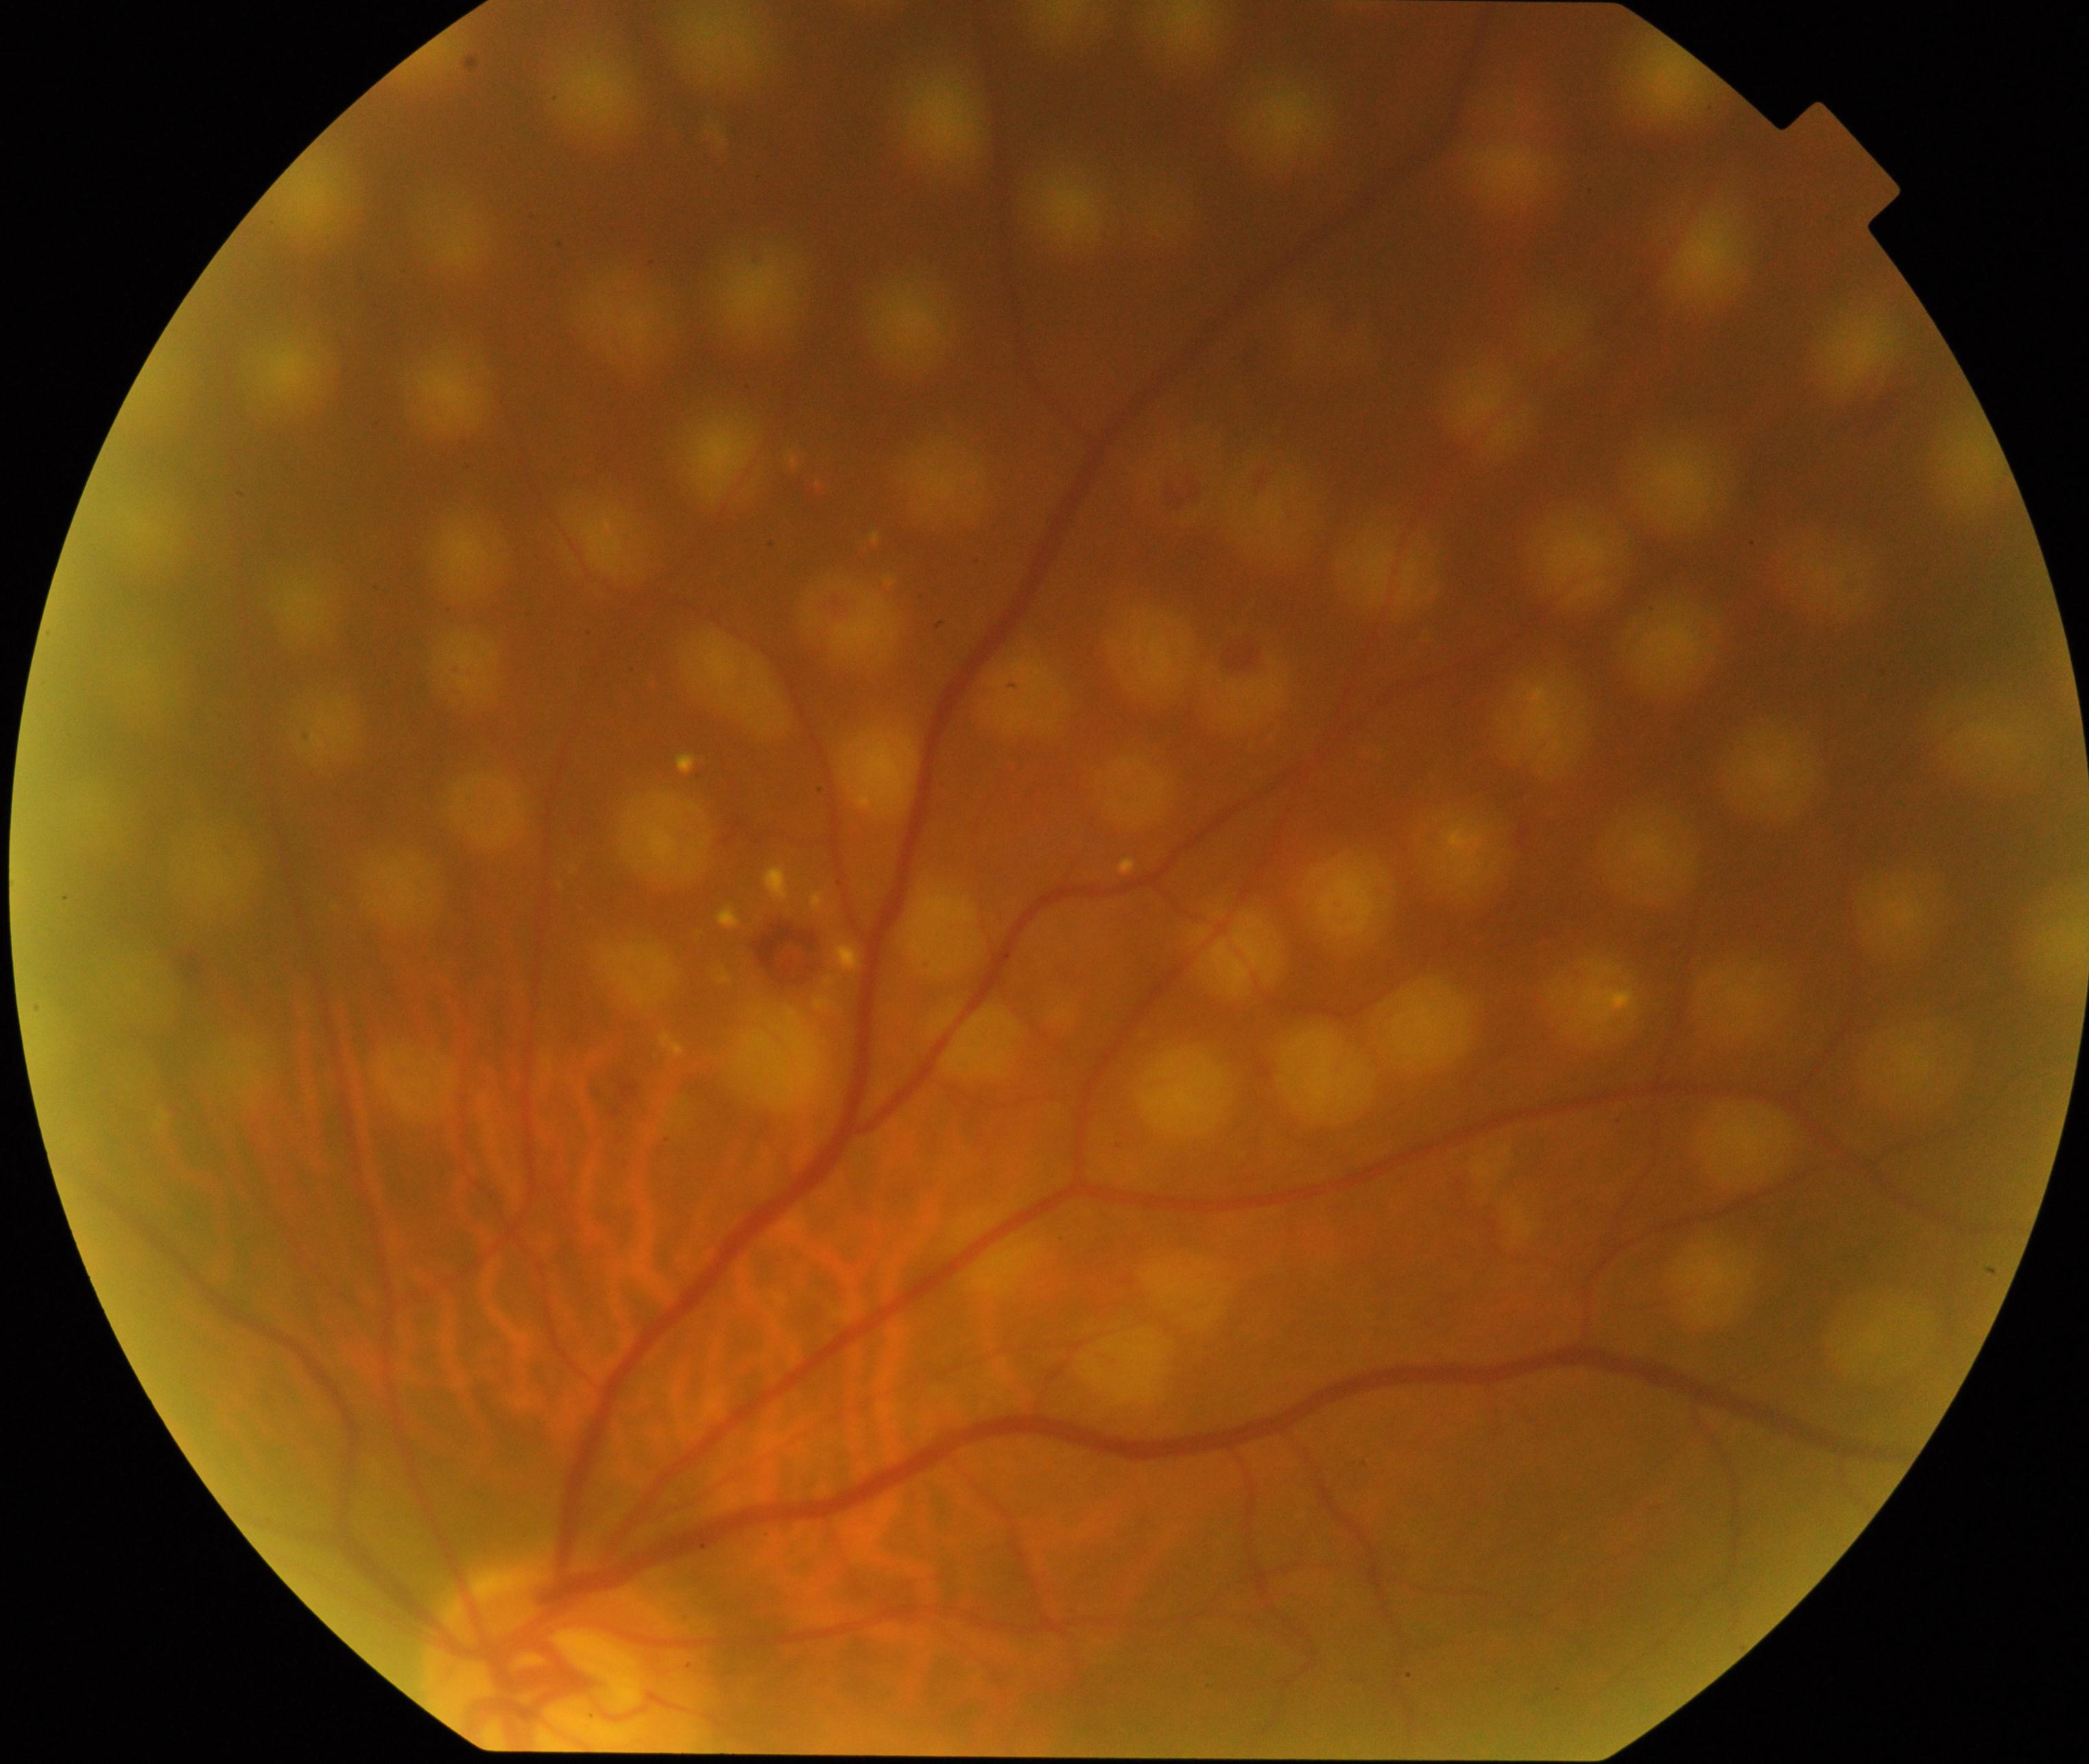

Color fundus photograph showing laser spots.